Diabetic retinopathy graded by the modified Davis classification
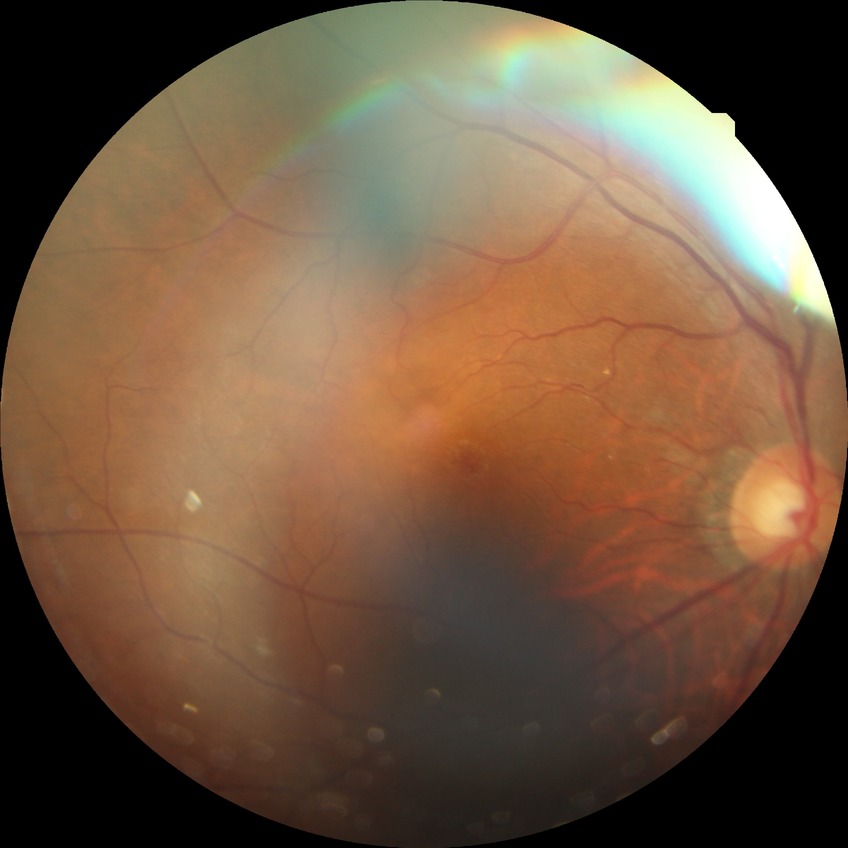 Diabetic retinopathy stage: no diabetic retinopathy.